45° field of view. Nonmydriatic fundus photograph. 848 x 848 pixels. Camera: NIDEK AFC-230. Fundus photo: 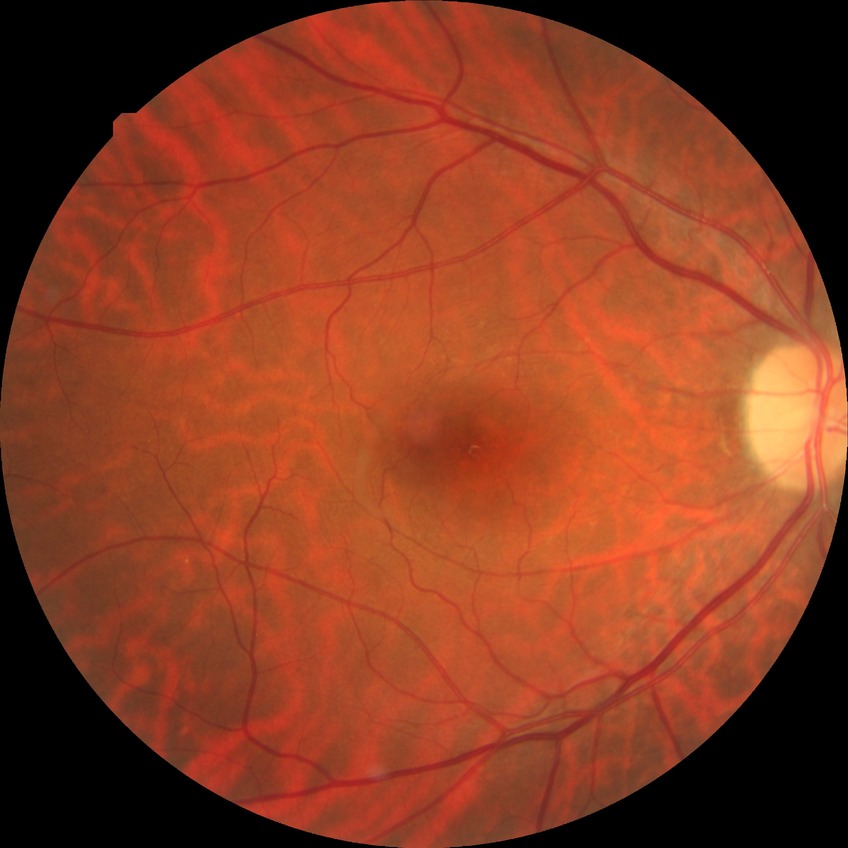
No apparent diabetic retinopathy.
Davis DR grade: NDR.